1440x1080; 130° field of view (Natus RetCam Envision); wide-field fundus photograph of an infant
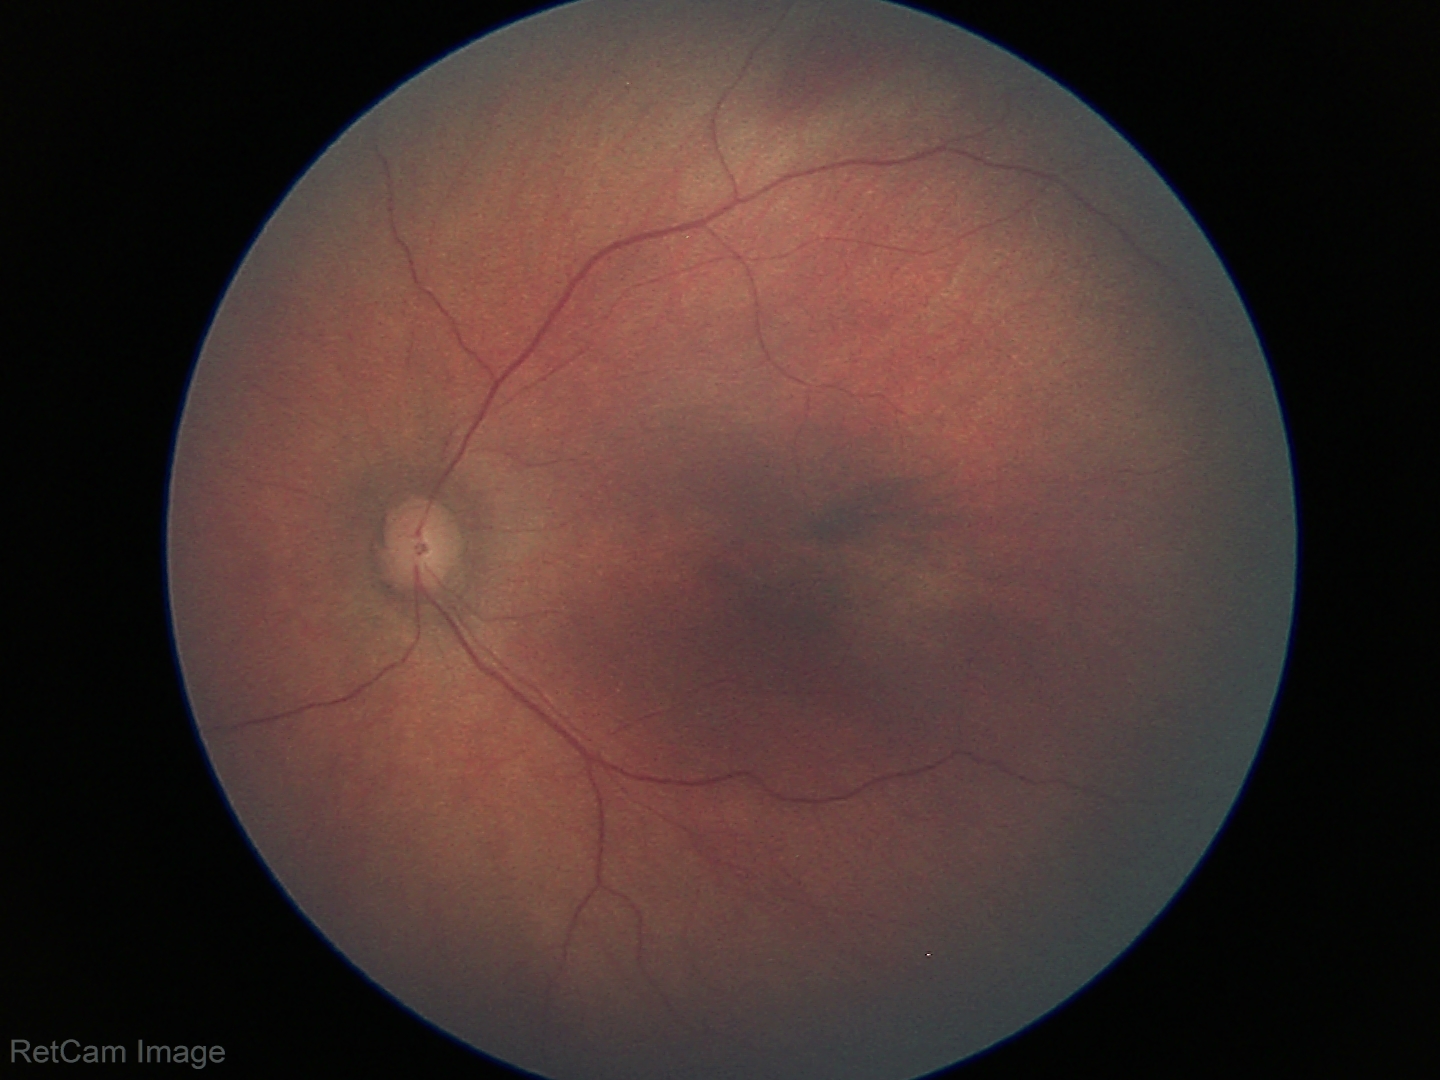 Screening diagnosis: normal.